DR severity per modified Davis staging: 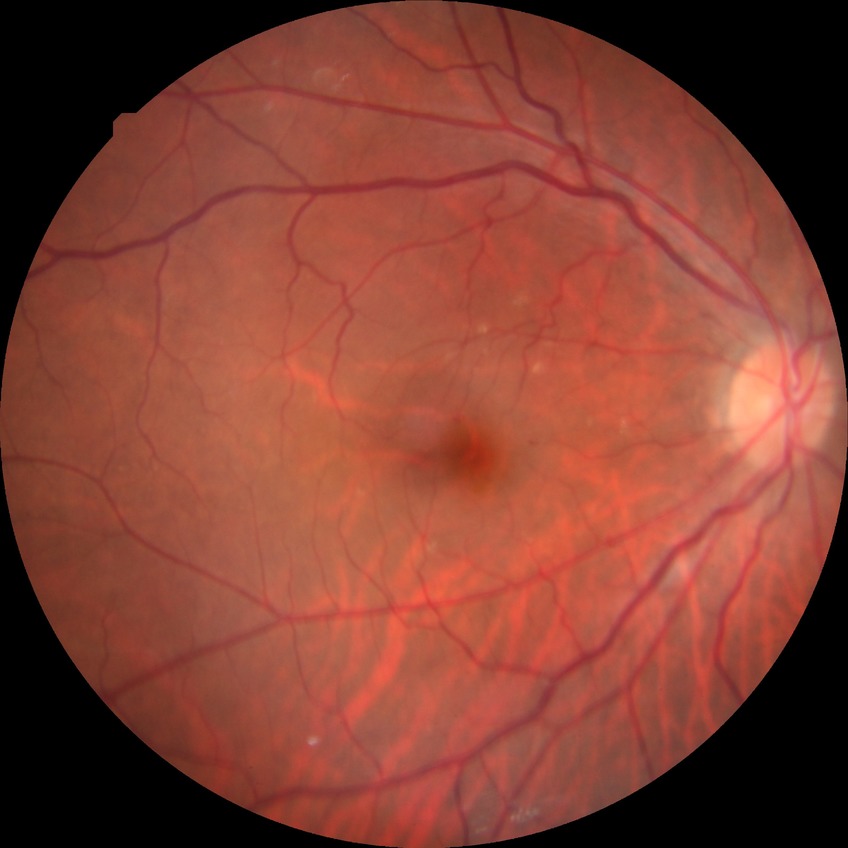

diabetic retinopathy (DR)=NDR (no diabetic retinopathy).